45° FOV, nonmydriatic fundus photograph, modified Davis classification:
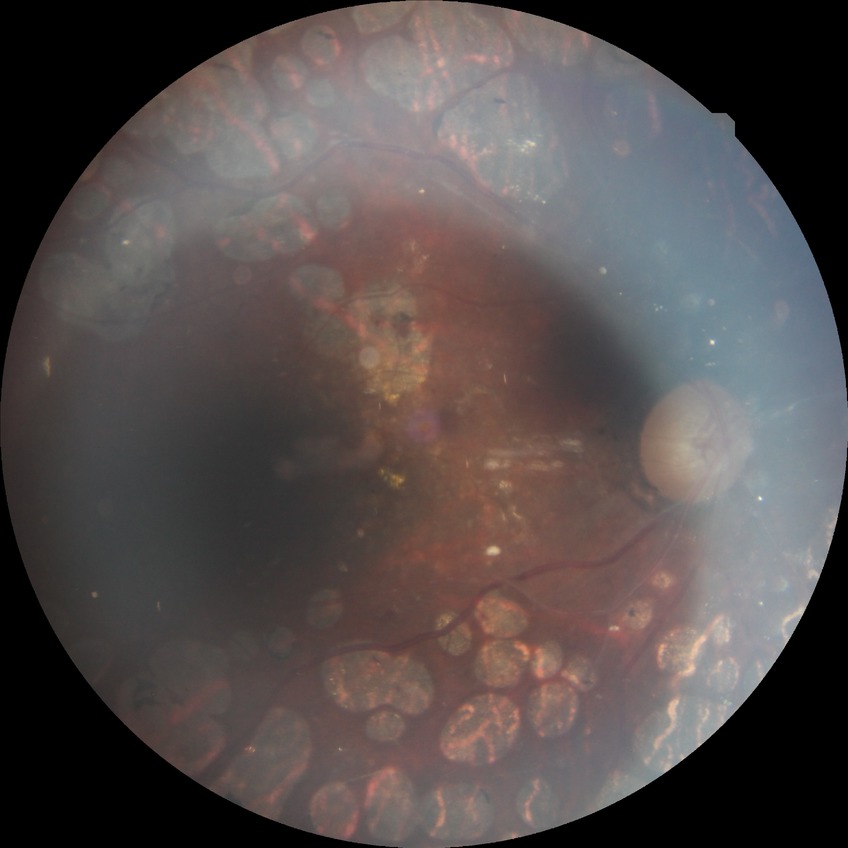
Assessment:
* diabetic retinopathy (DR) — proliferative diabetic retinopathy (PDR)